Remidio Fundus on Phone (FOP) camera. Image size 1659x2212 — 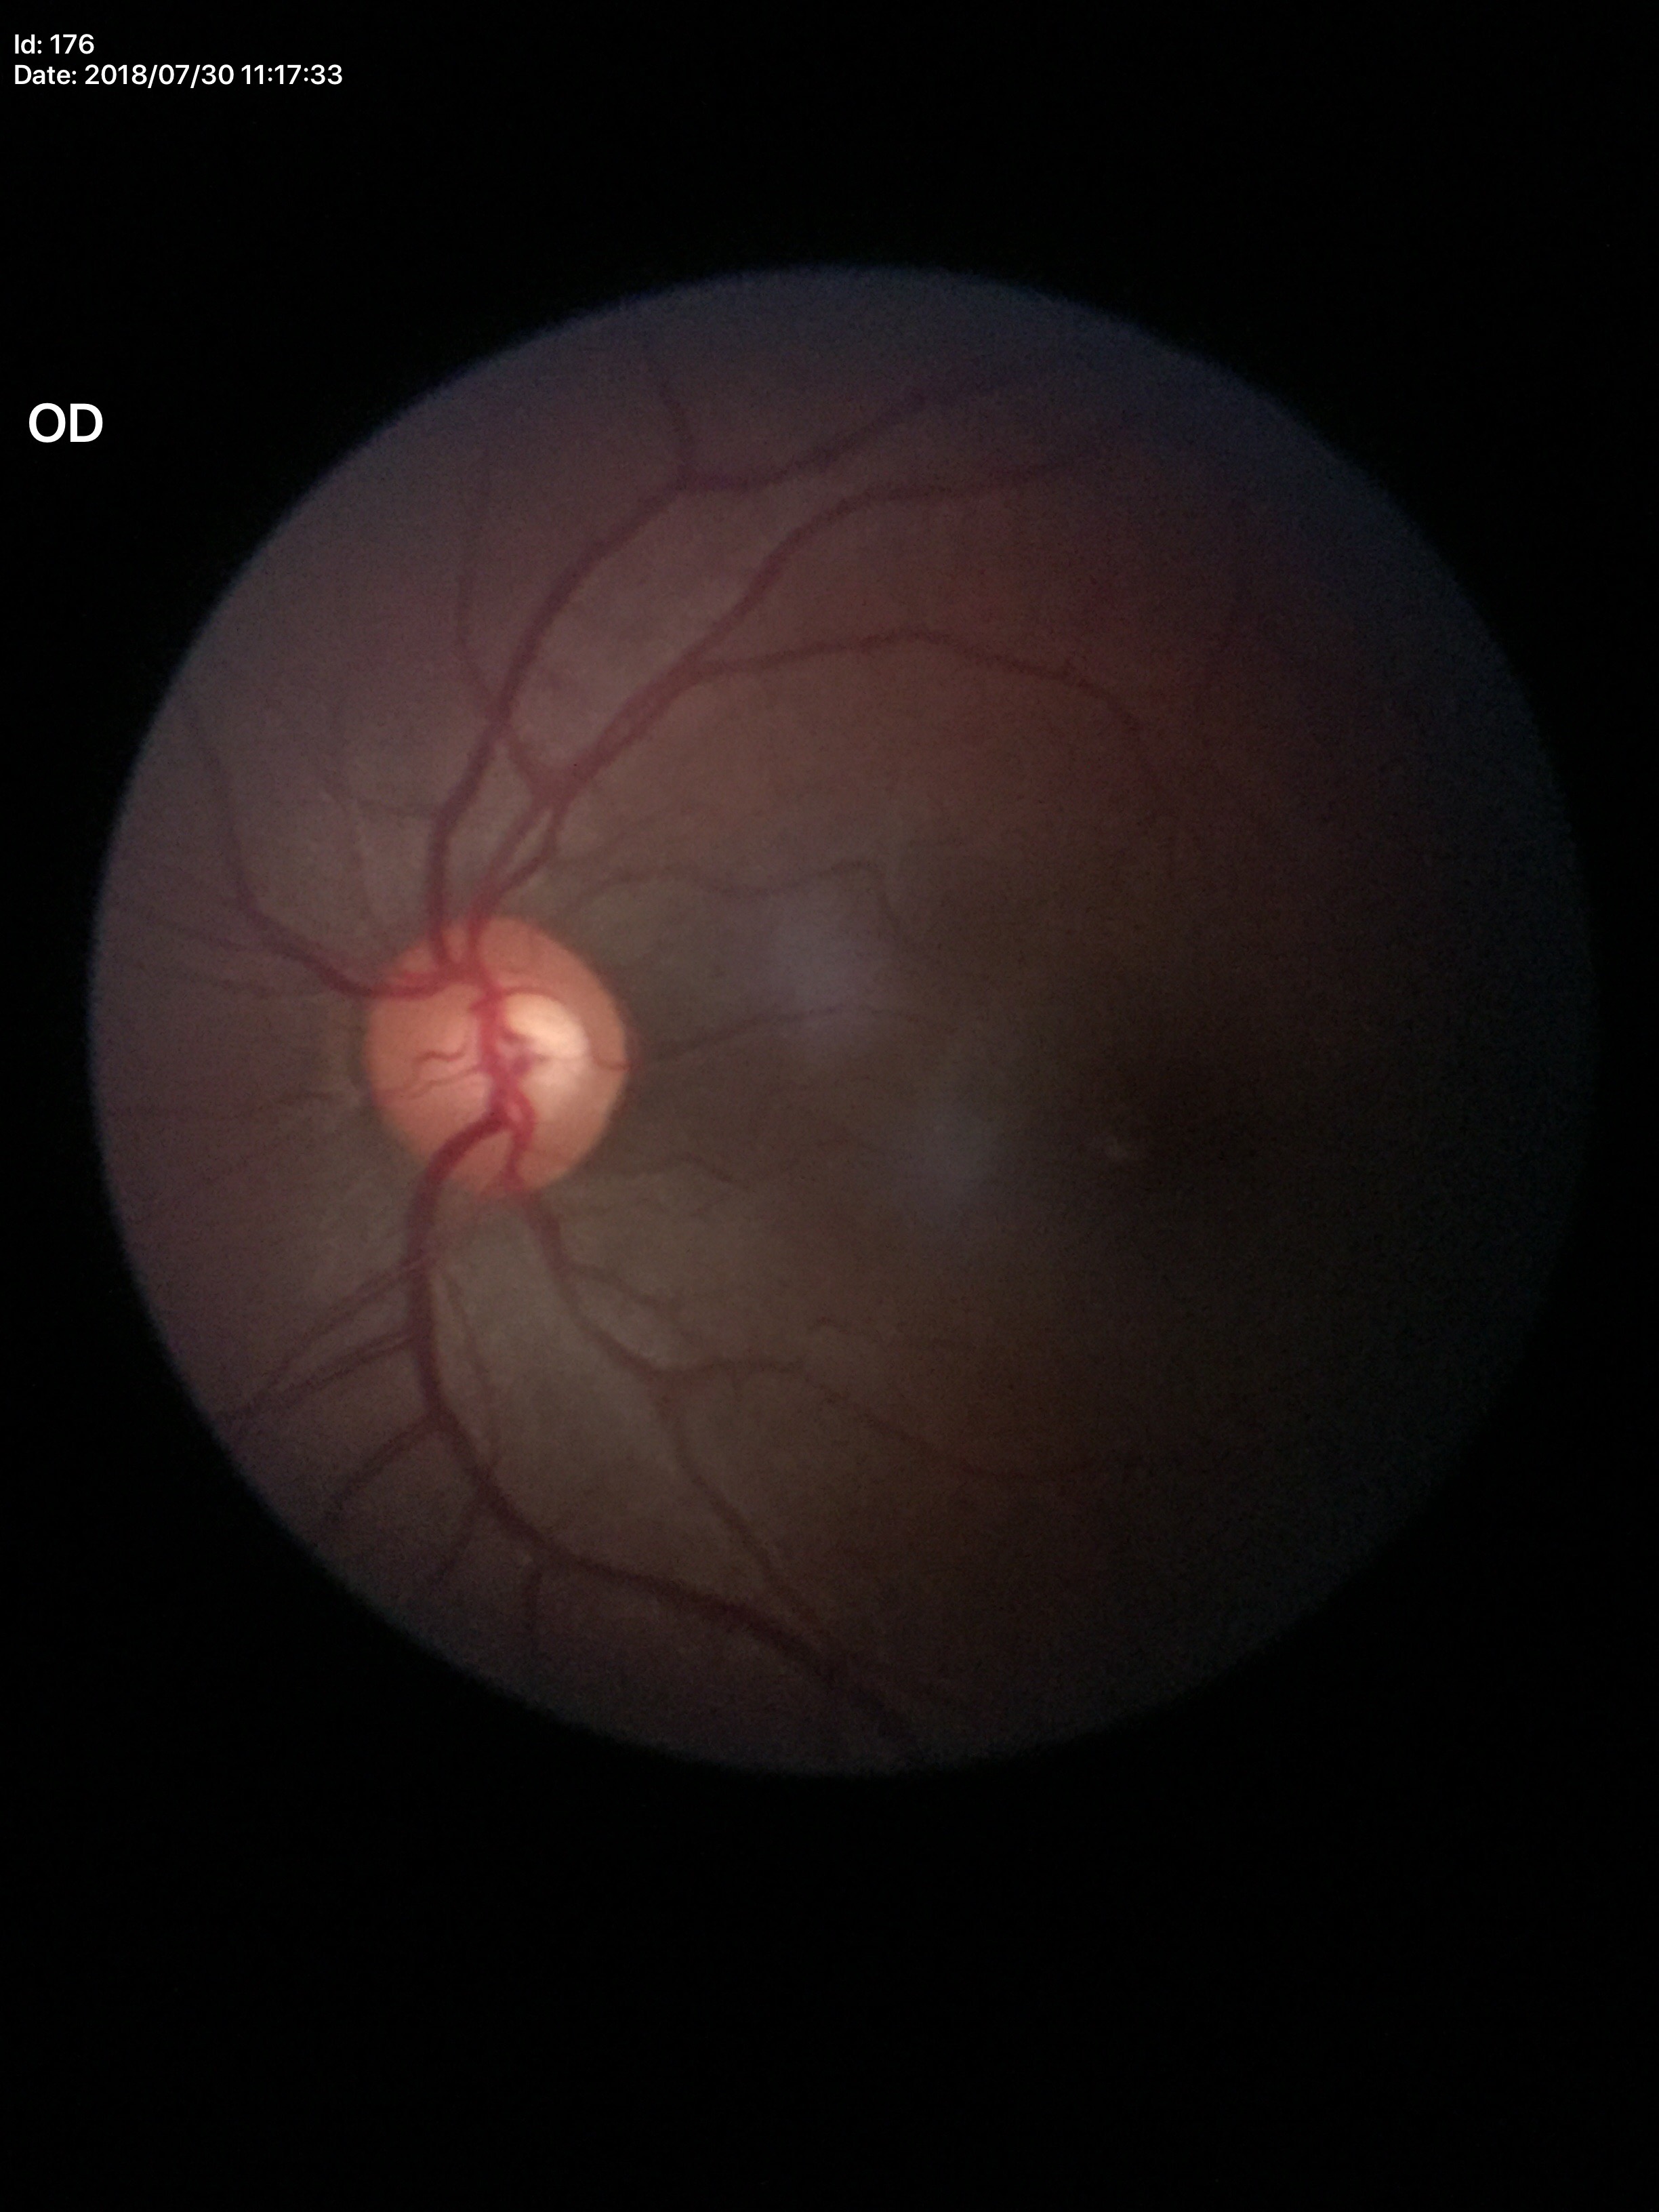
horizontal C/D ratio (HCDR): 0.54 | Glaucoma evaluation: negative (5/5 ophthalmologists in agreement) | vertical cup-disc ratio (VCDR): 0.55.